Davis DR grading — 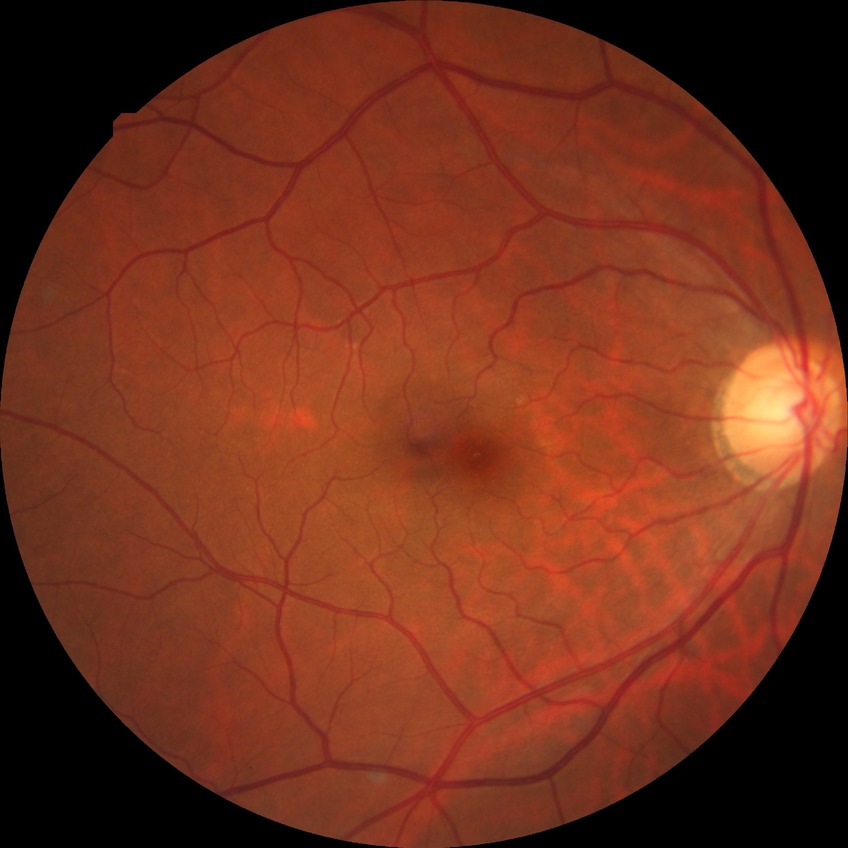

Diabetic retinopathy (DR) is NDR (no diabetic retinopathy).